45-degree field of view. Retinal fundus photograph — 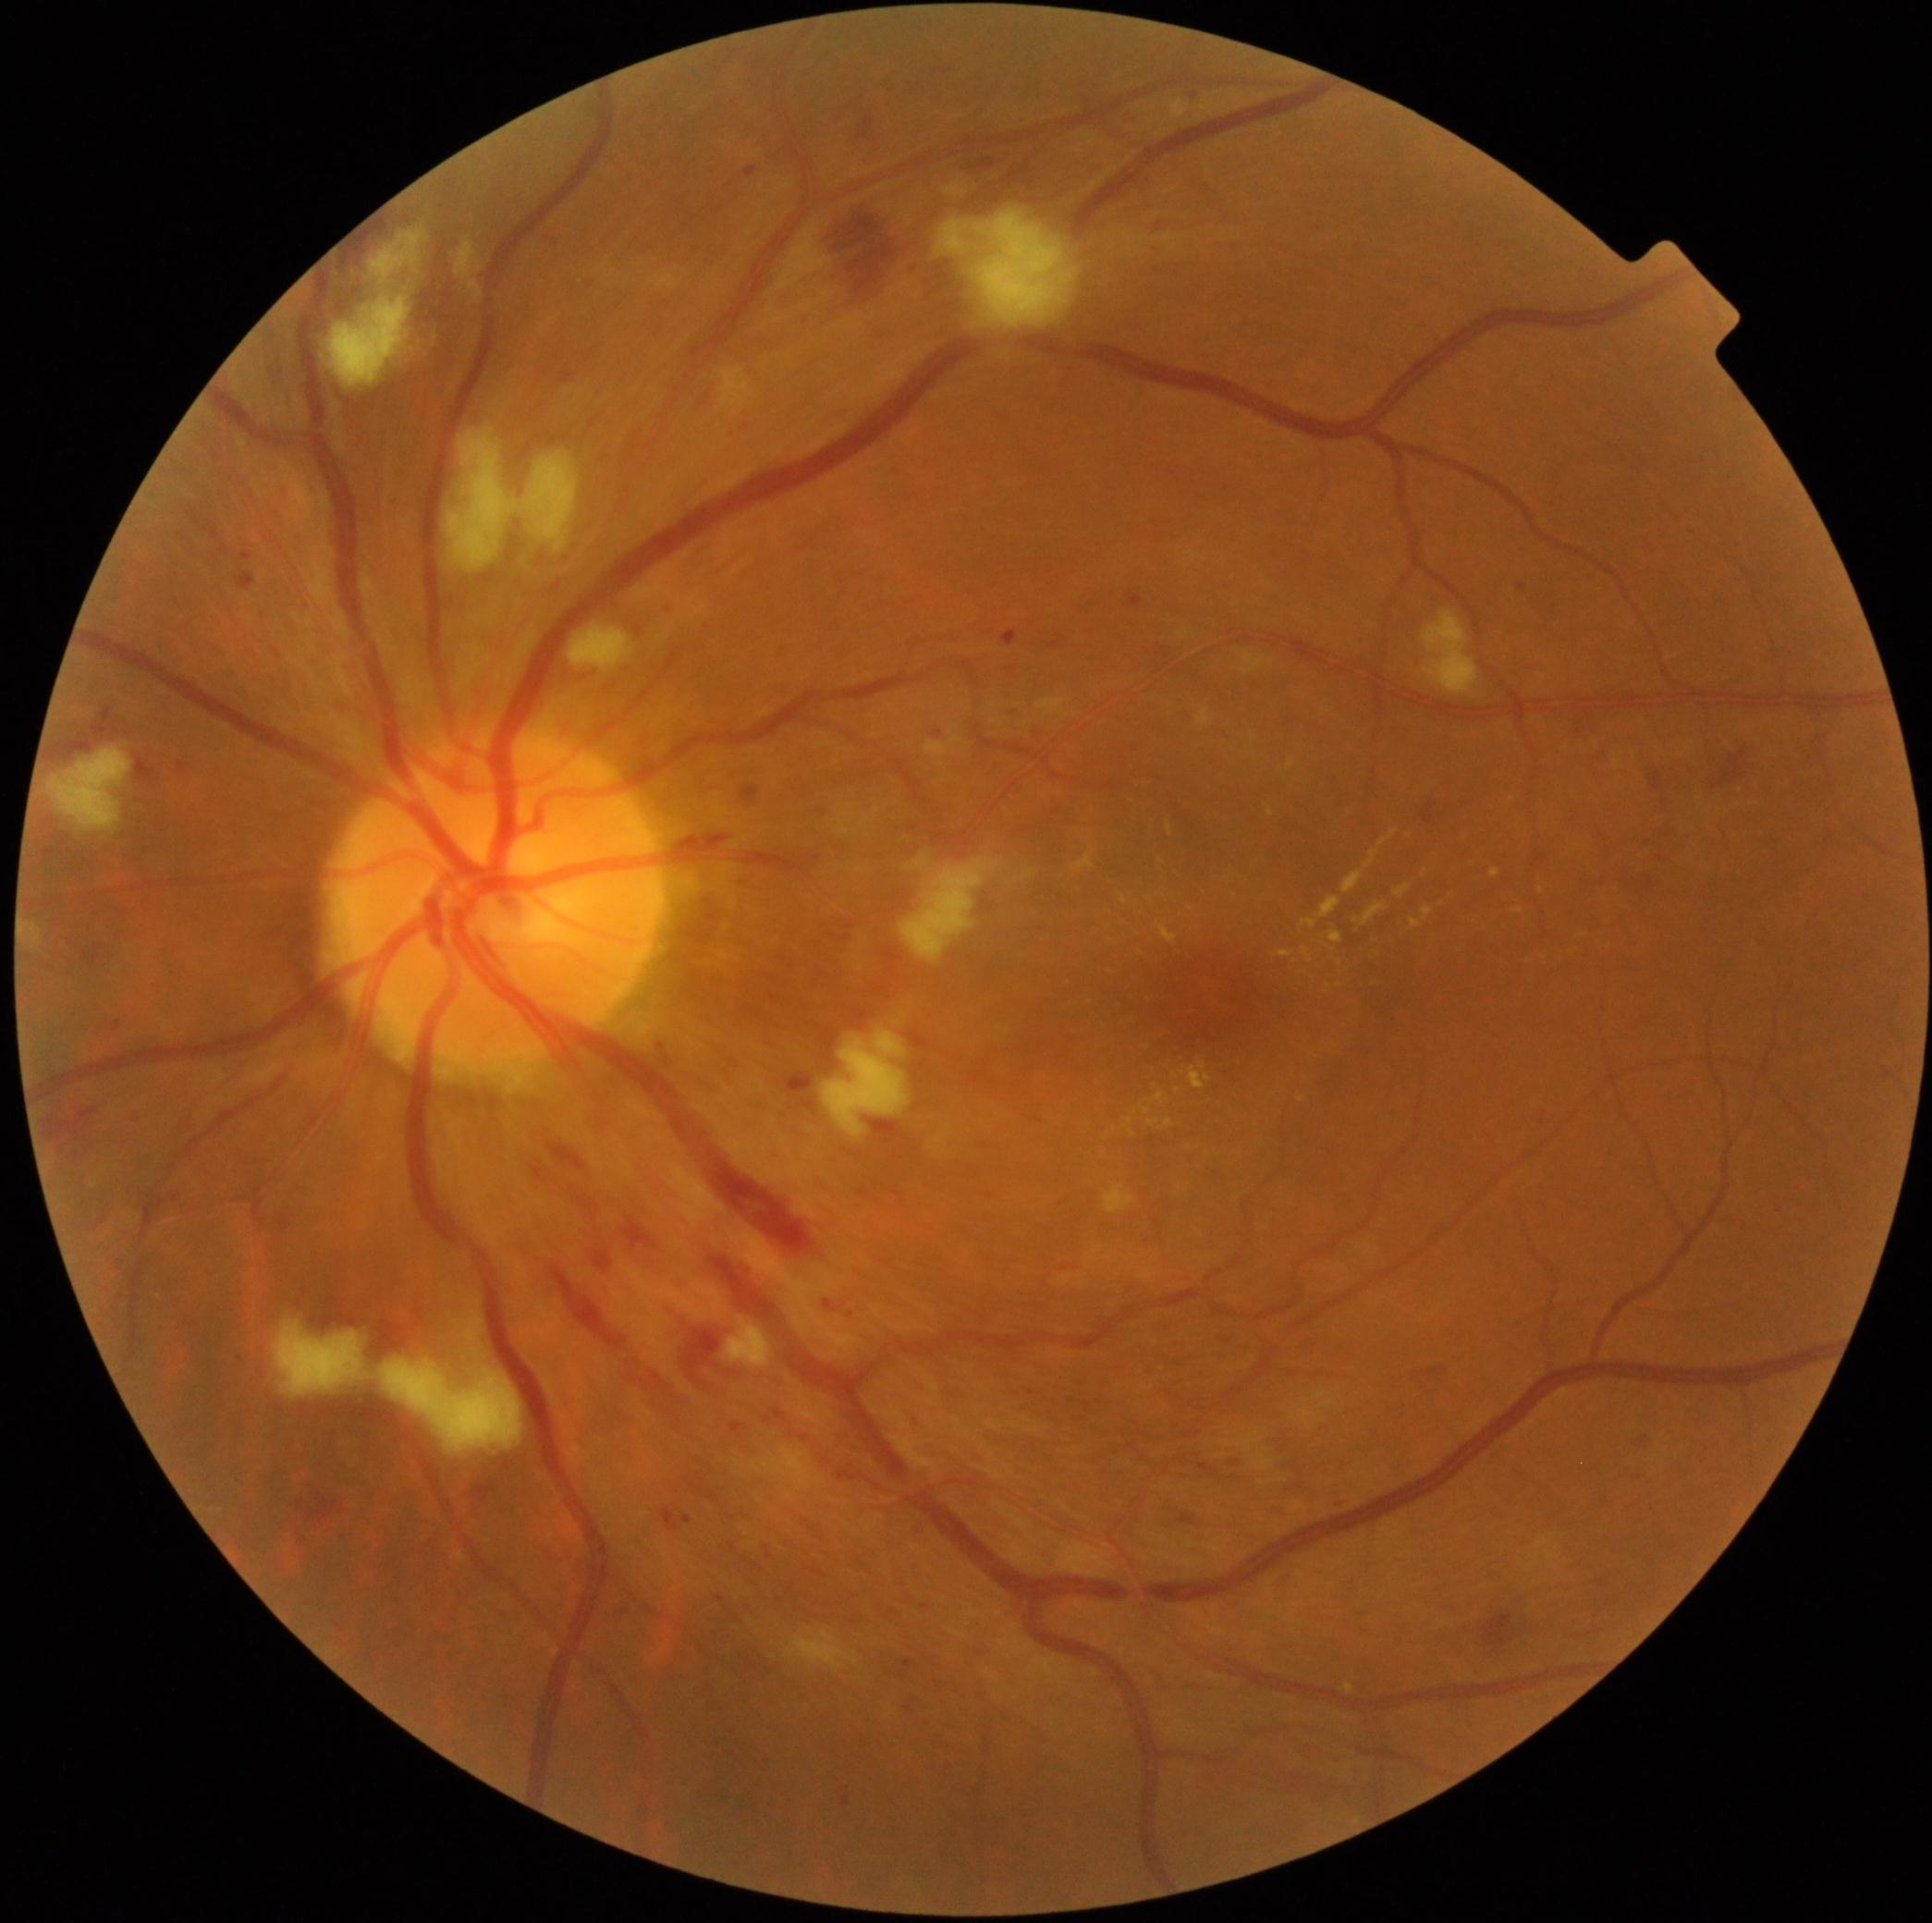

DR class: non-proliferative diabetic retinopathy.
Diabetic retinopathy (DR): 2.